45° FOV · 2048x1536: 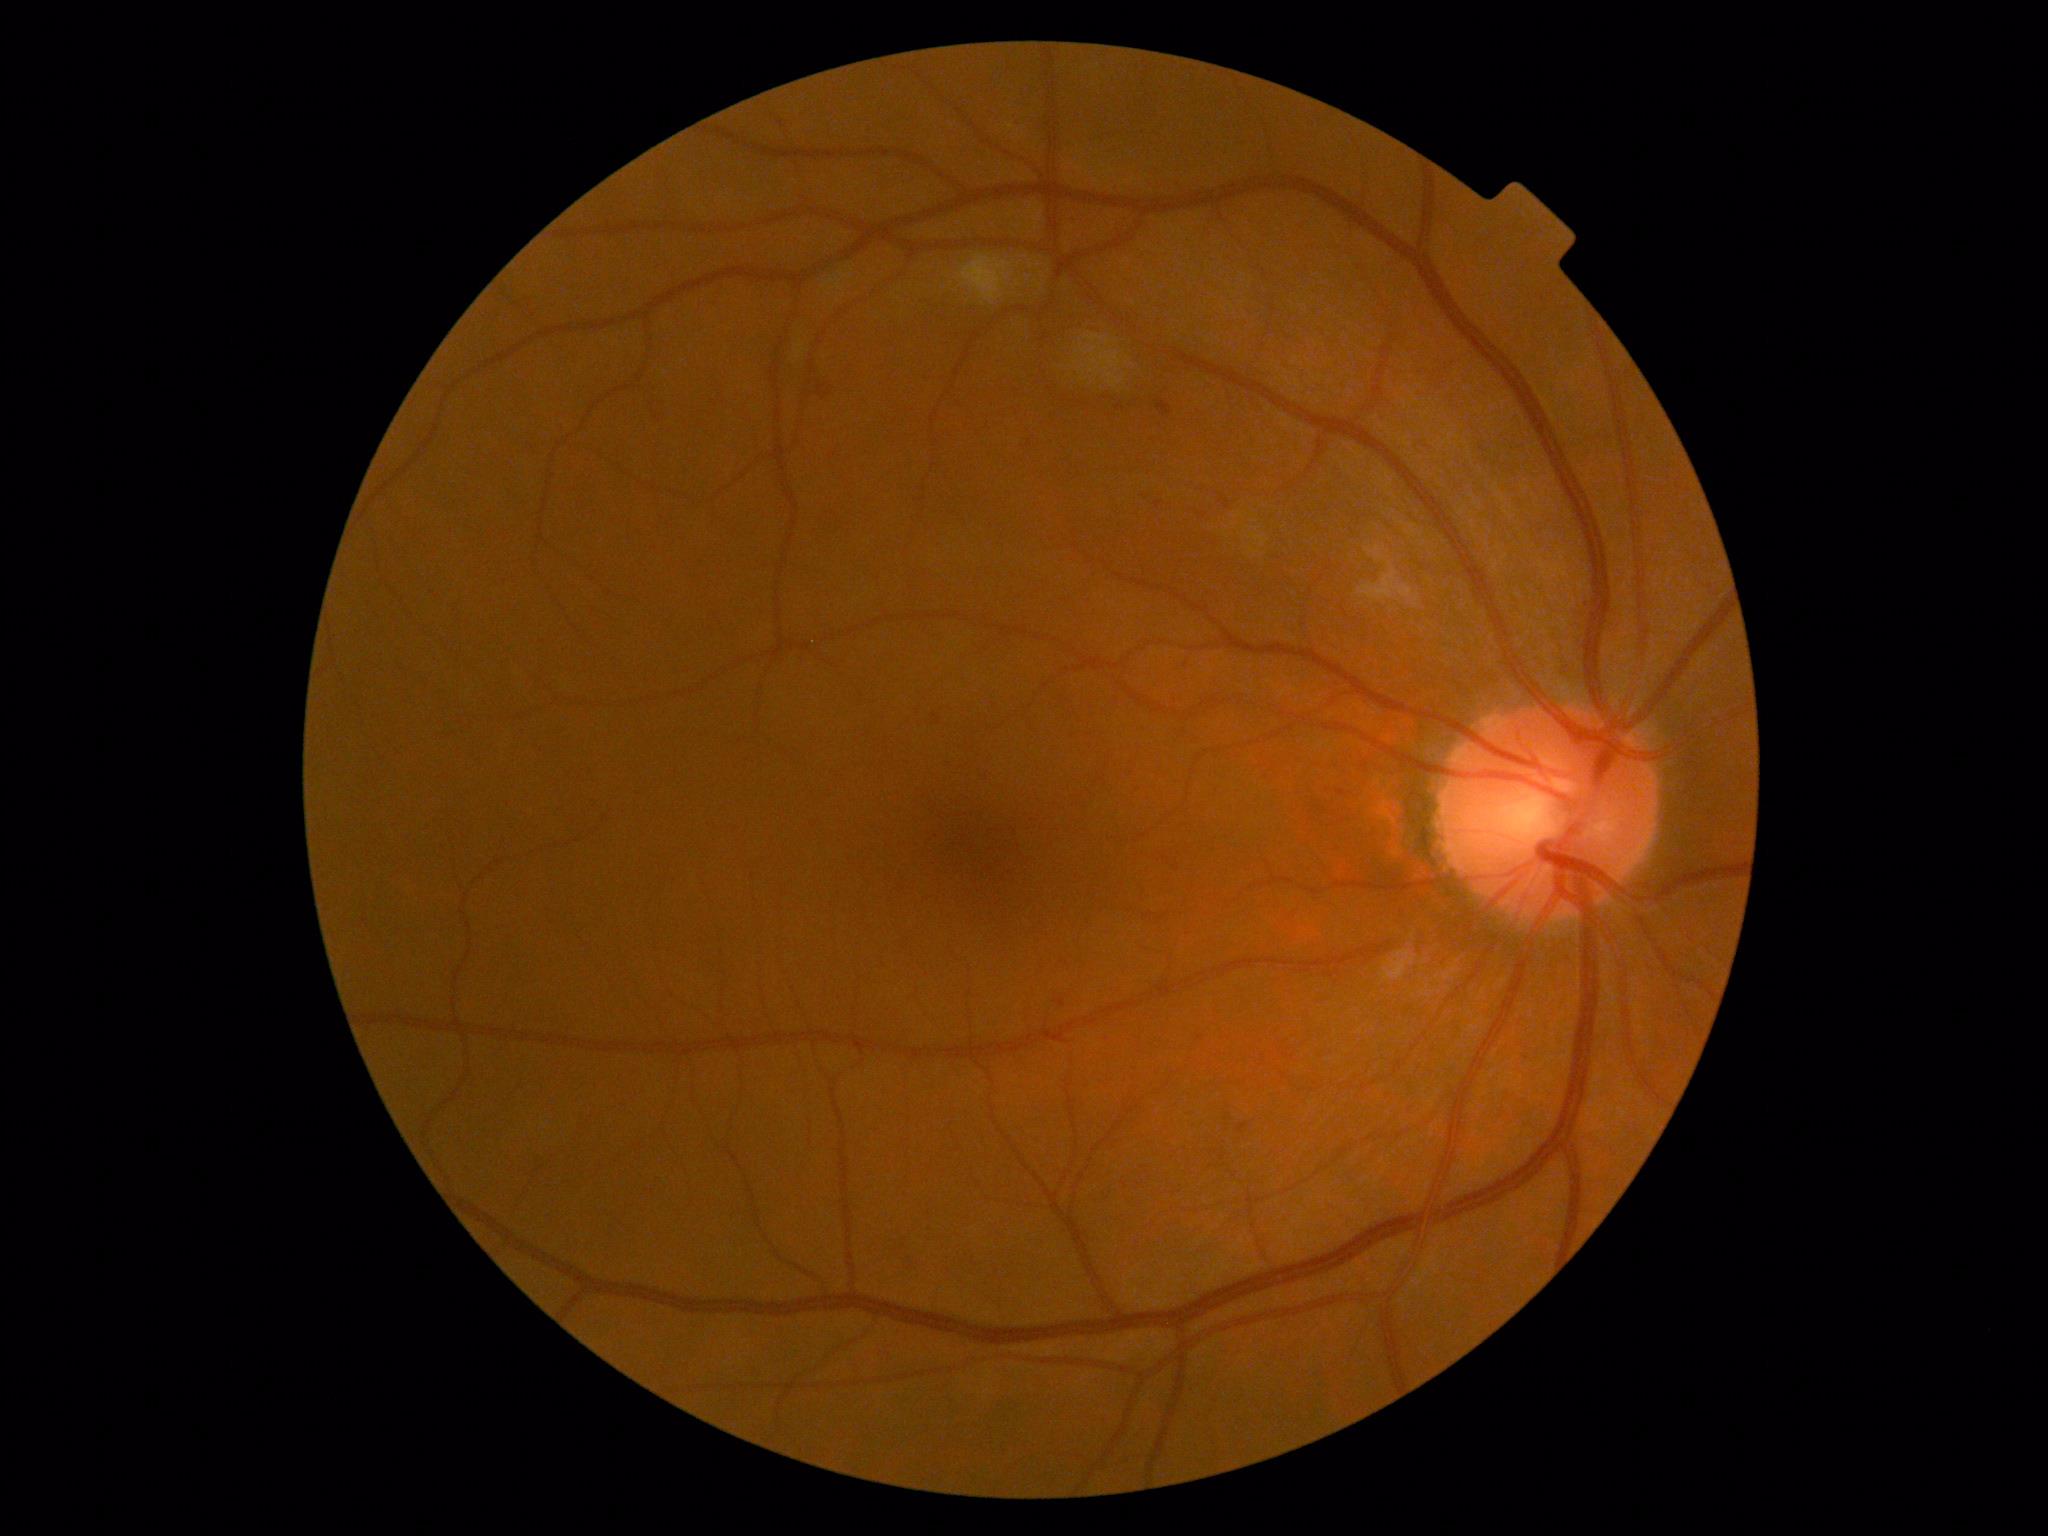 Retinopathy is 2.
The retinopathy is classified as non-proliferative diabetic retinopathy.